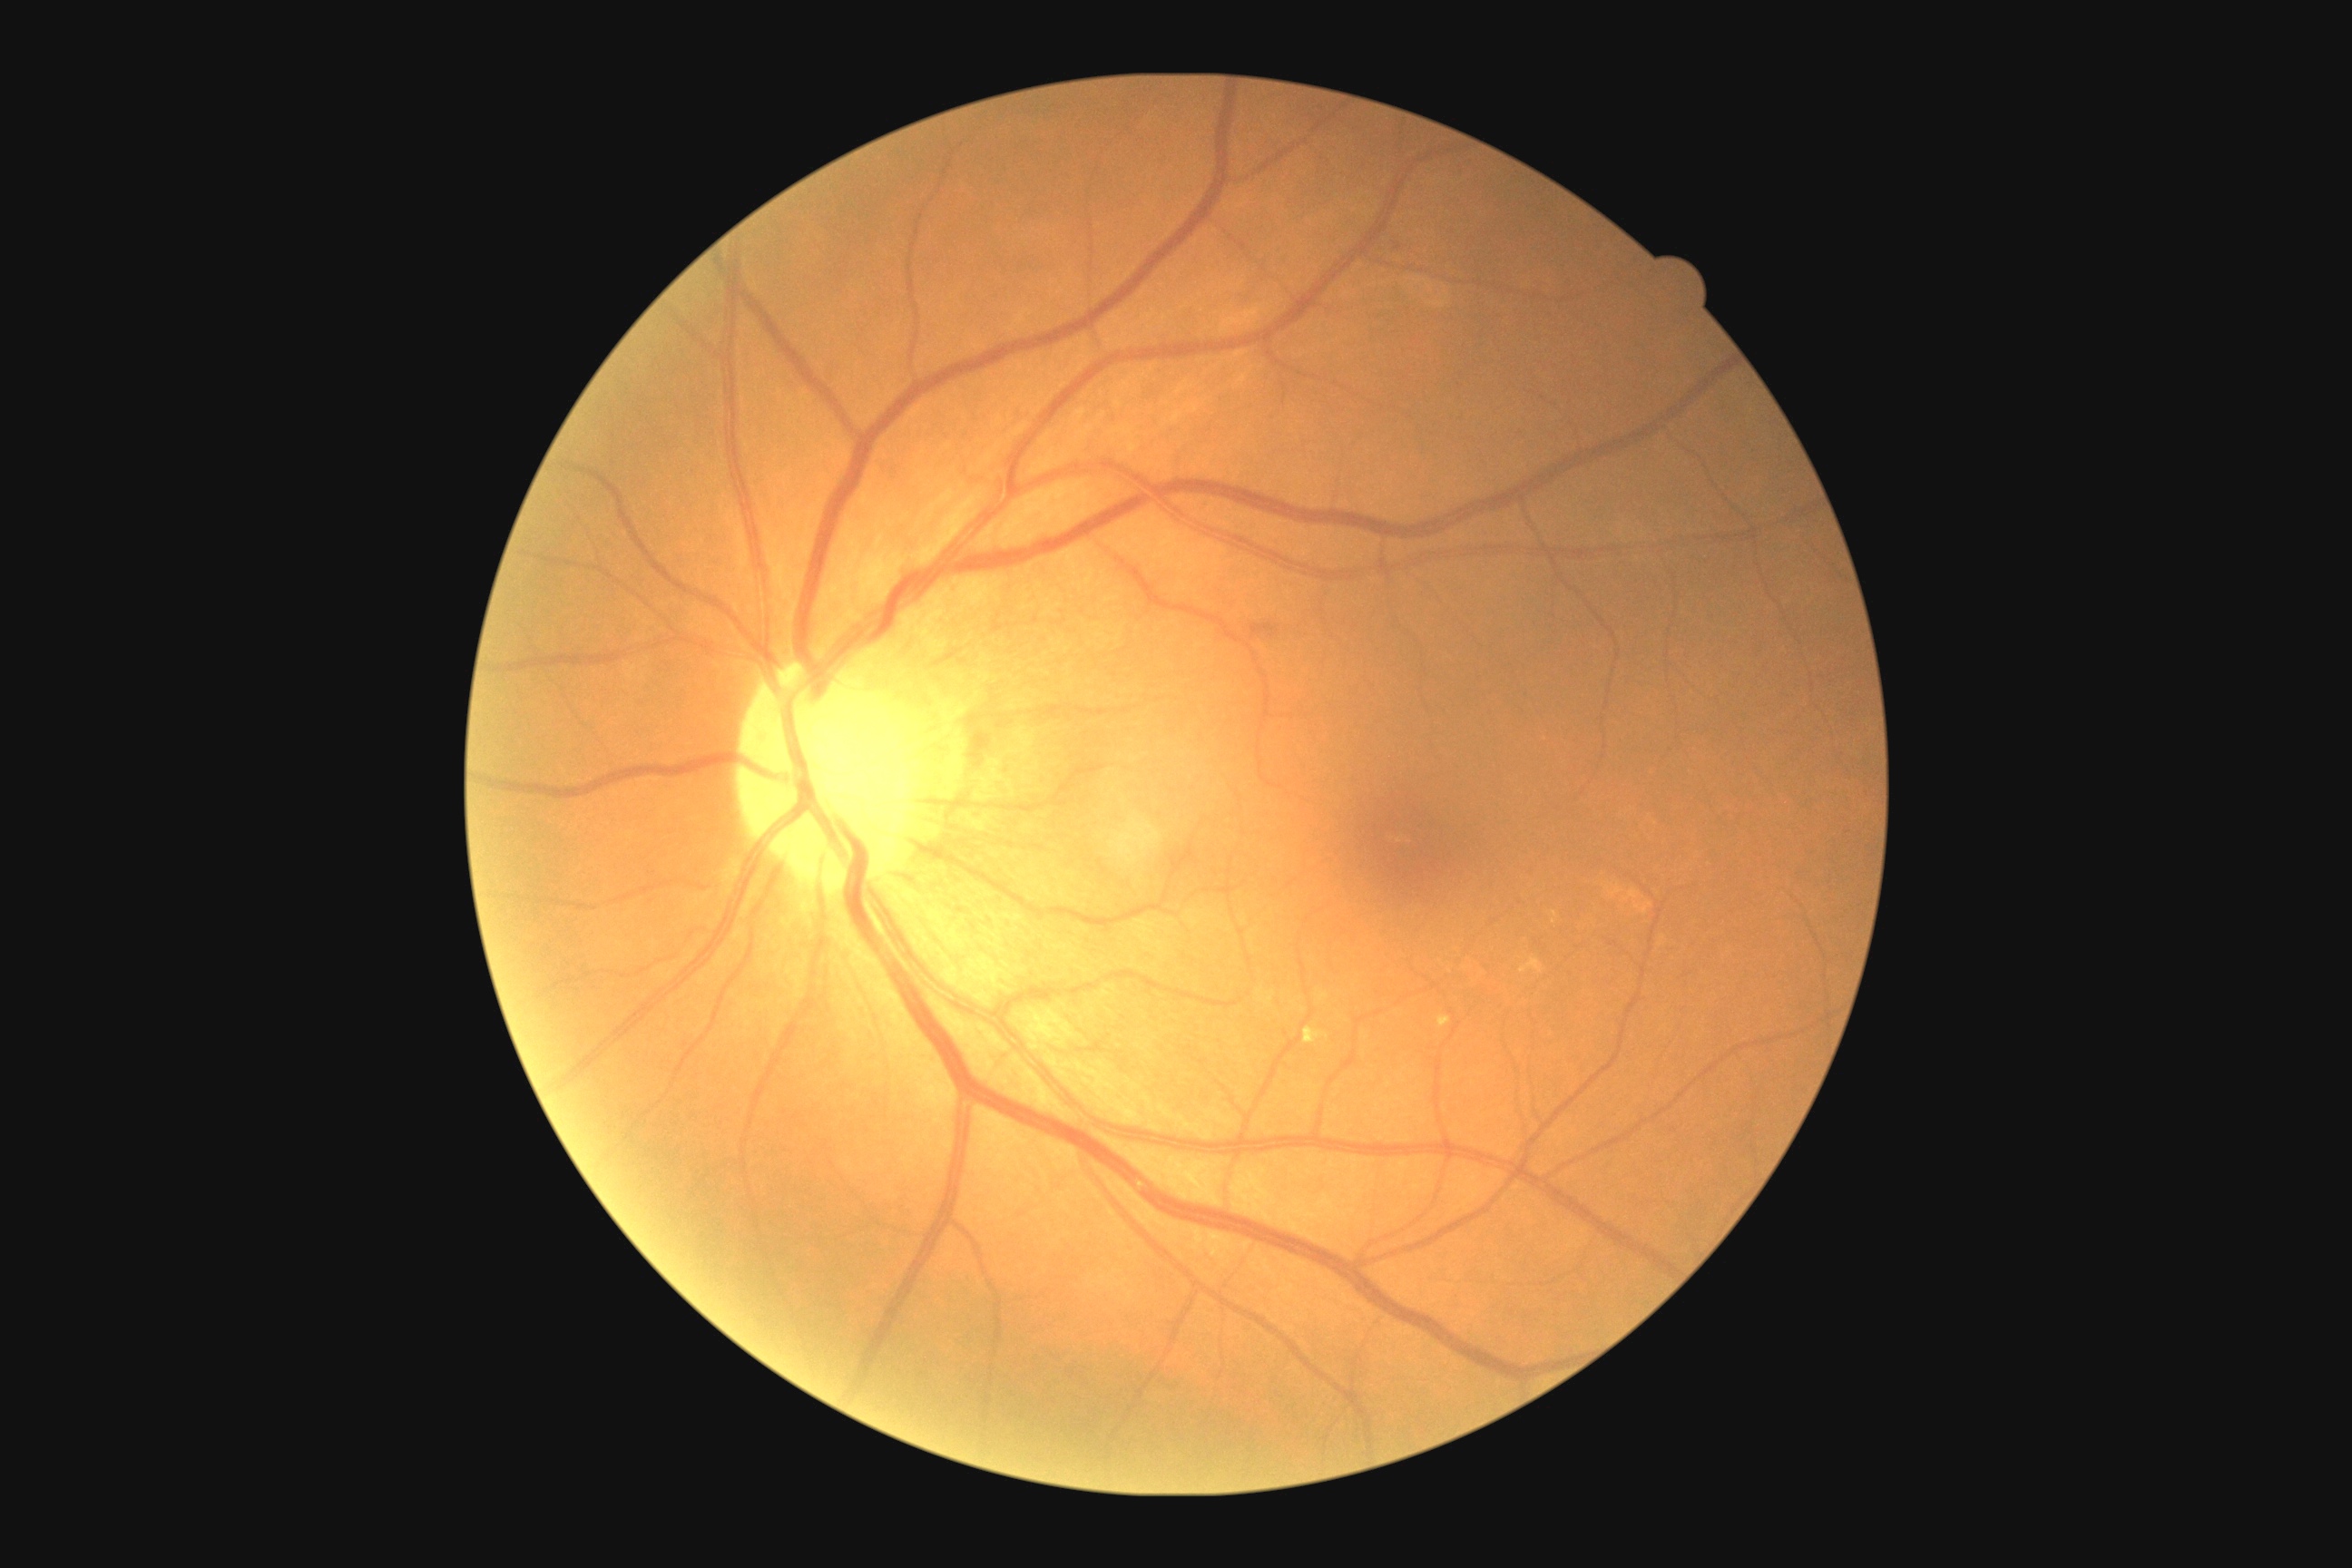 * DR class: non-proliferative diabetic retinopathy
* diabetic retinopathy (DR): grade 2 (moderate NPDR) — more than just microaneurysms but less than severe NPDR